45° field of view: 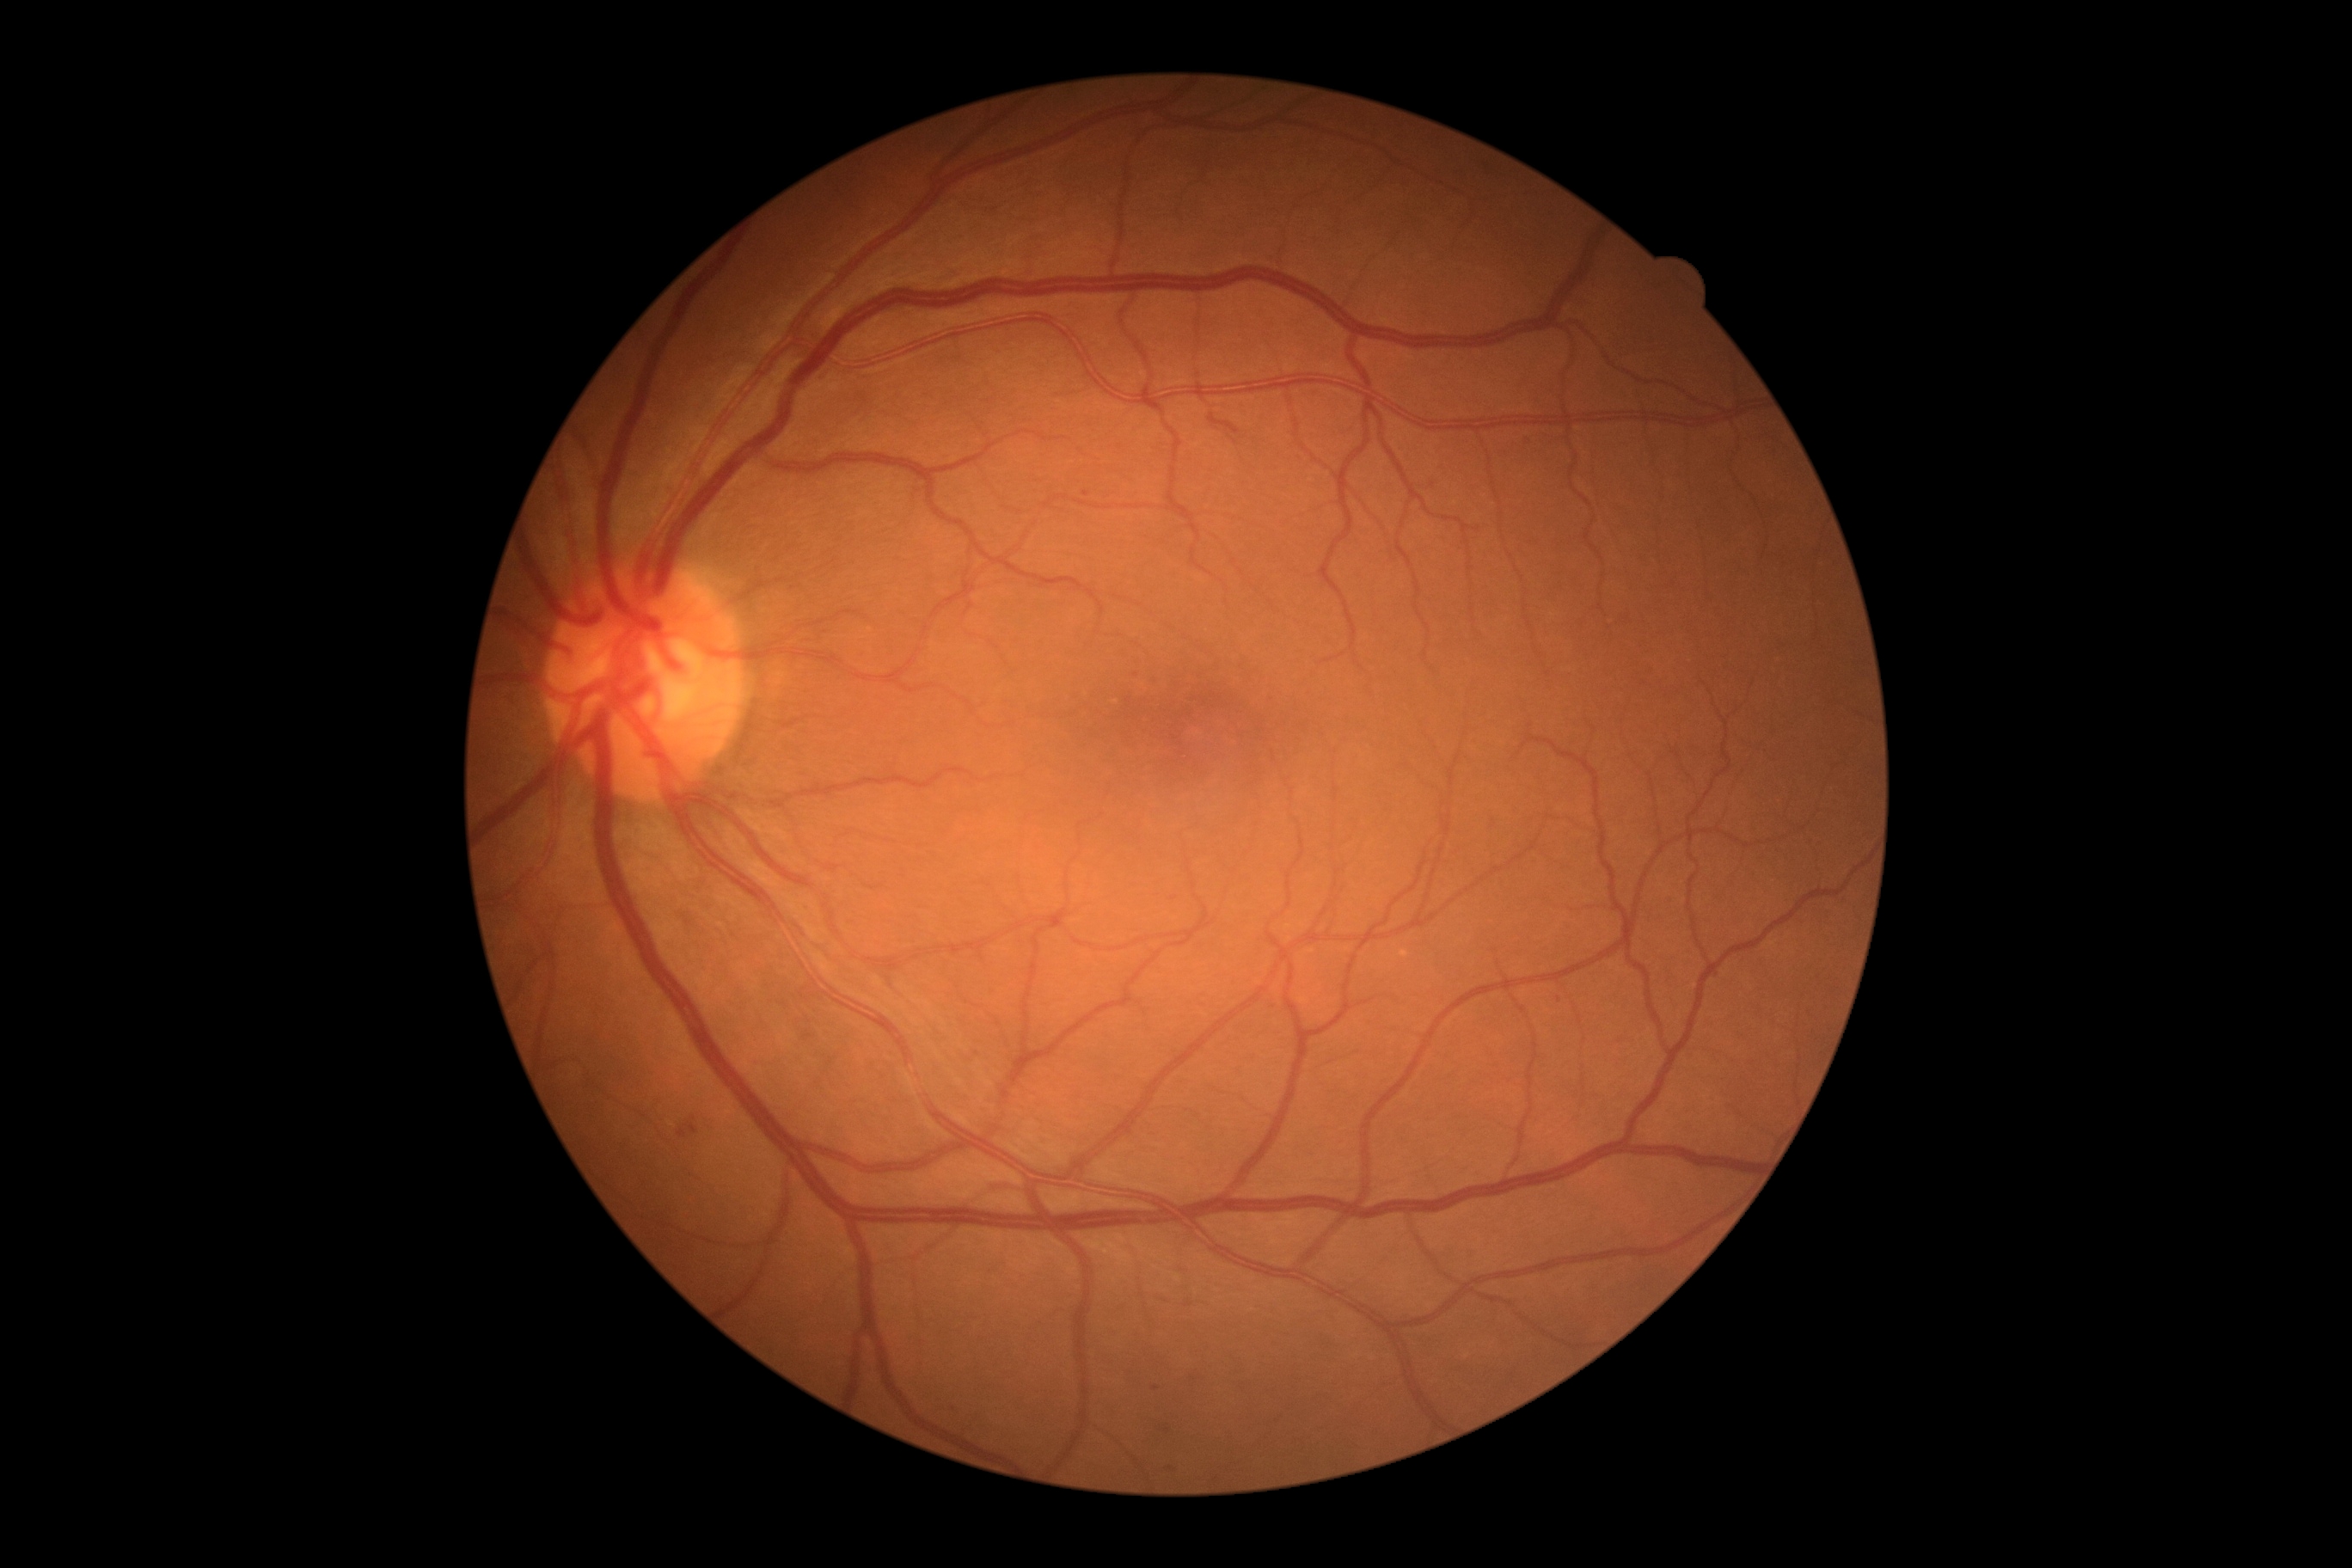

{
  "dr_grade": "grade 1 (mild NPDR)"
}